Color fundus photograph centered on the optic disc, image size 469x469.
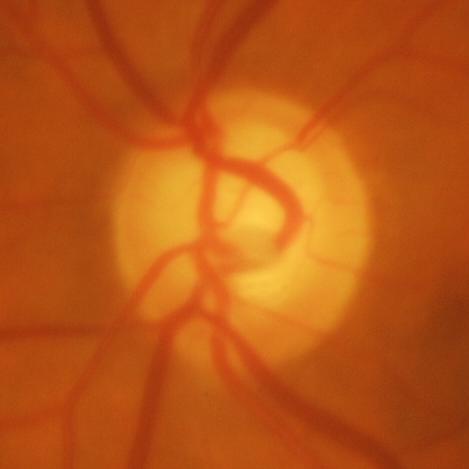
Glaucoma is present. Findings consistent with evidence of glaucoma.